Image size 1240x1240; infant wide-field fundus photograph; camera: Phoenix ICON (100° FOV):
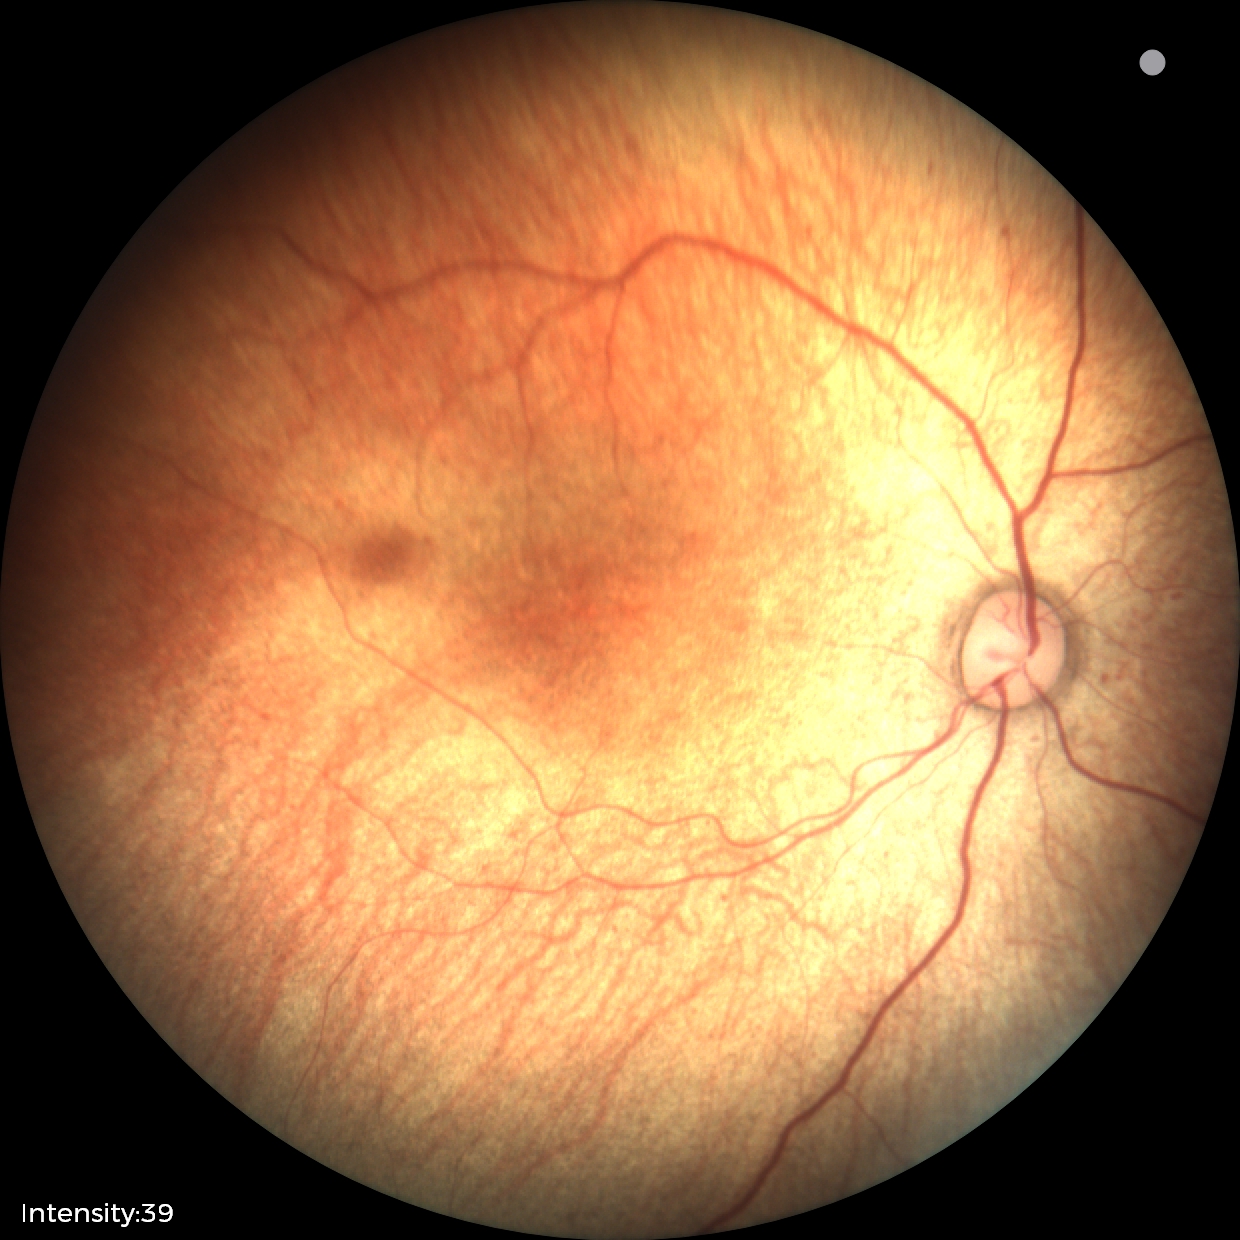
Examination with physiological retinal findings.